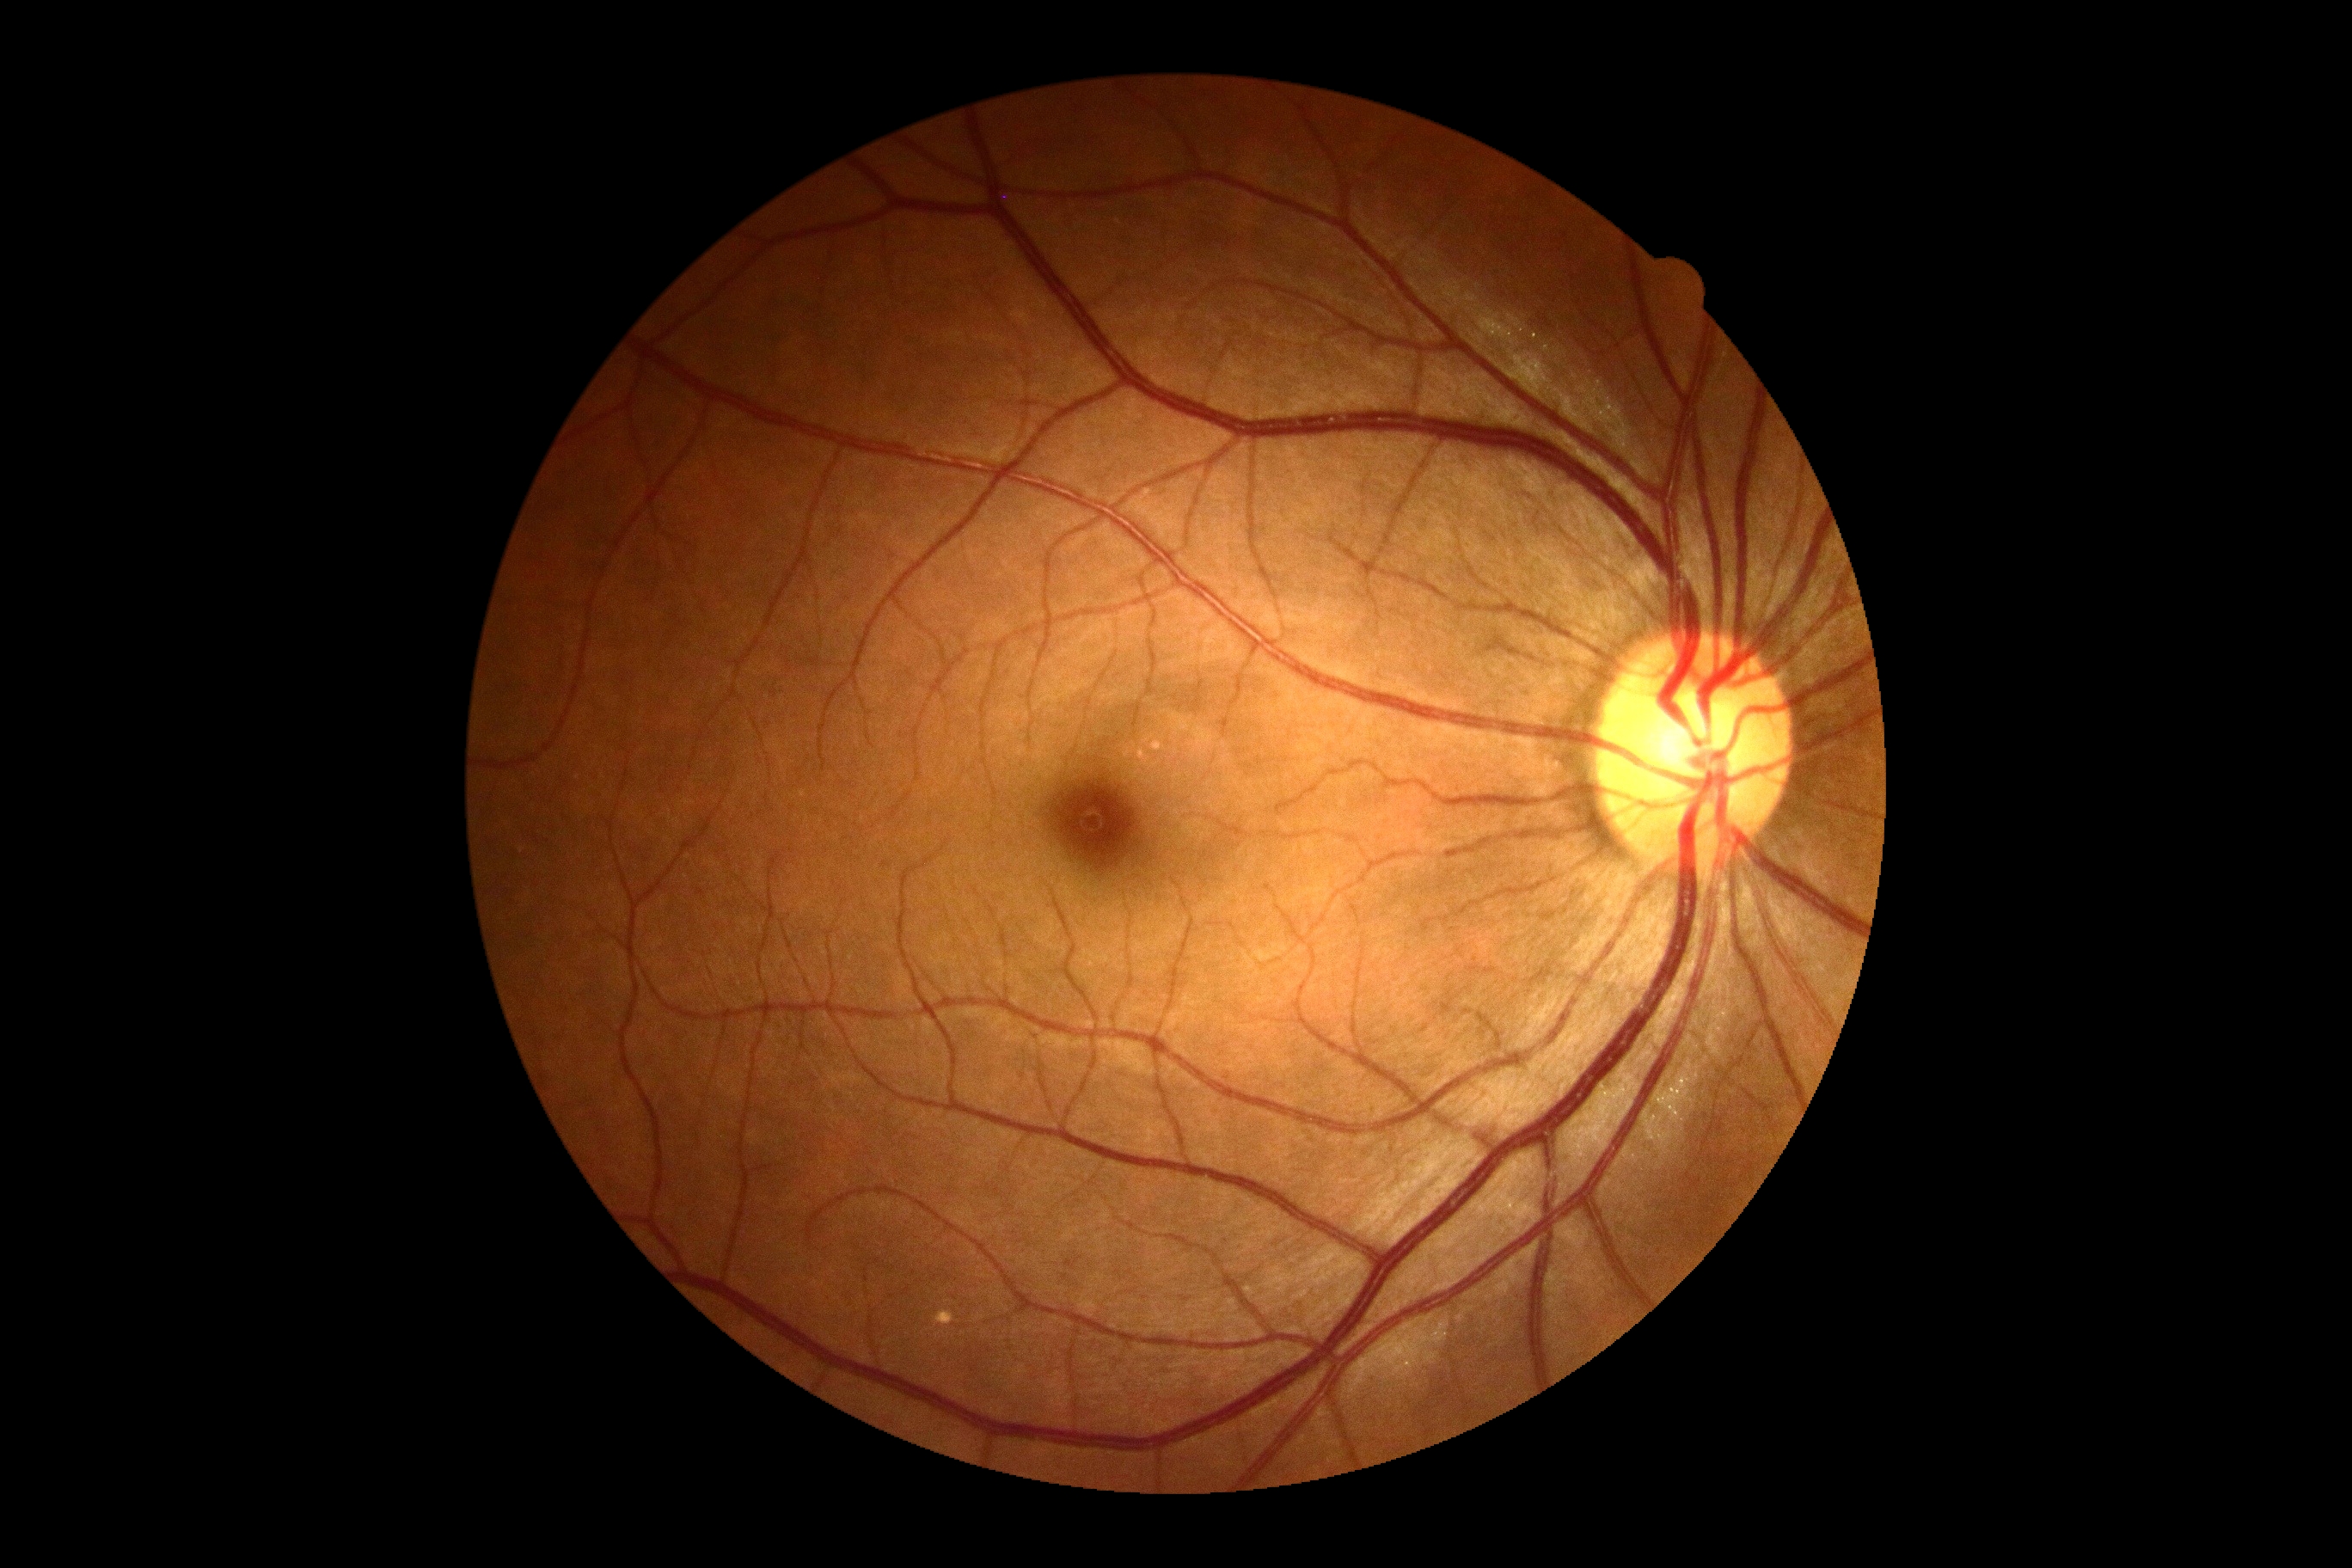
dr_impression: negative for DR
dr_grade: no apparent retinopathy (grade 0)